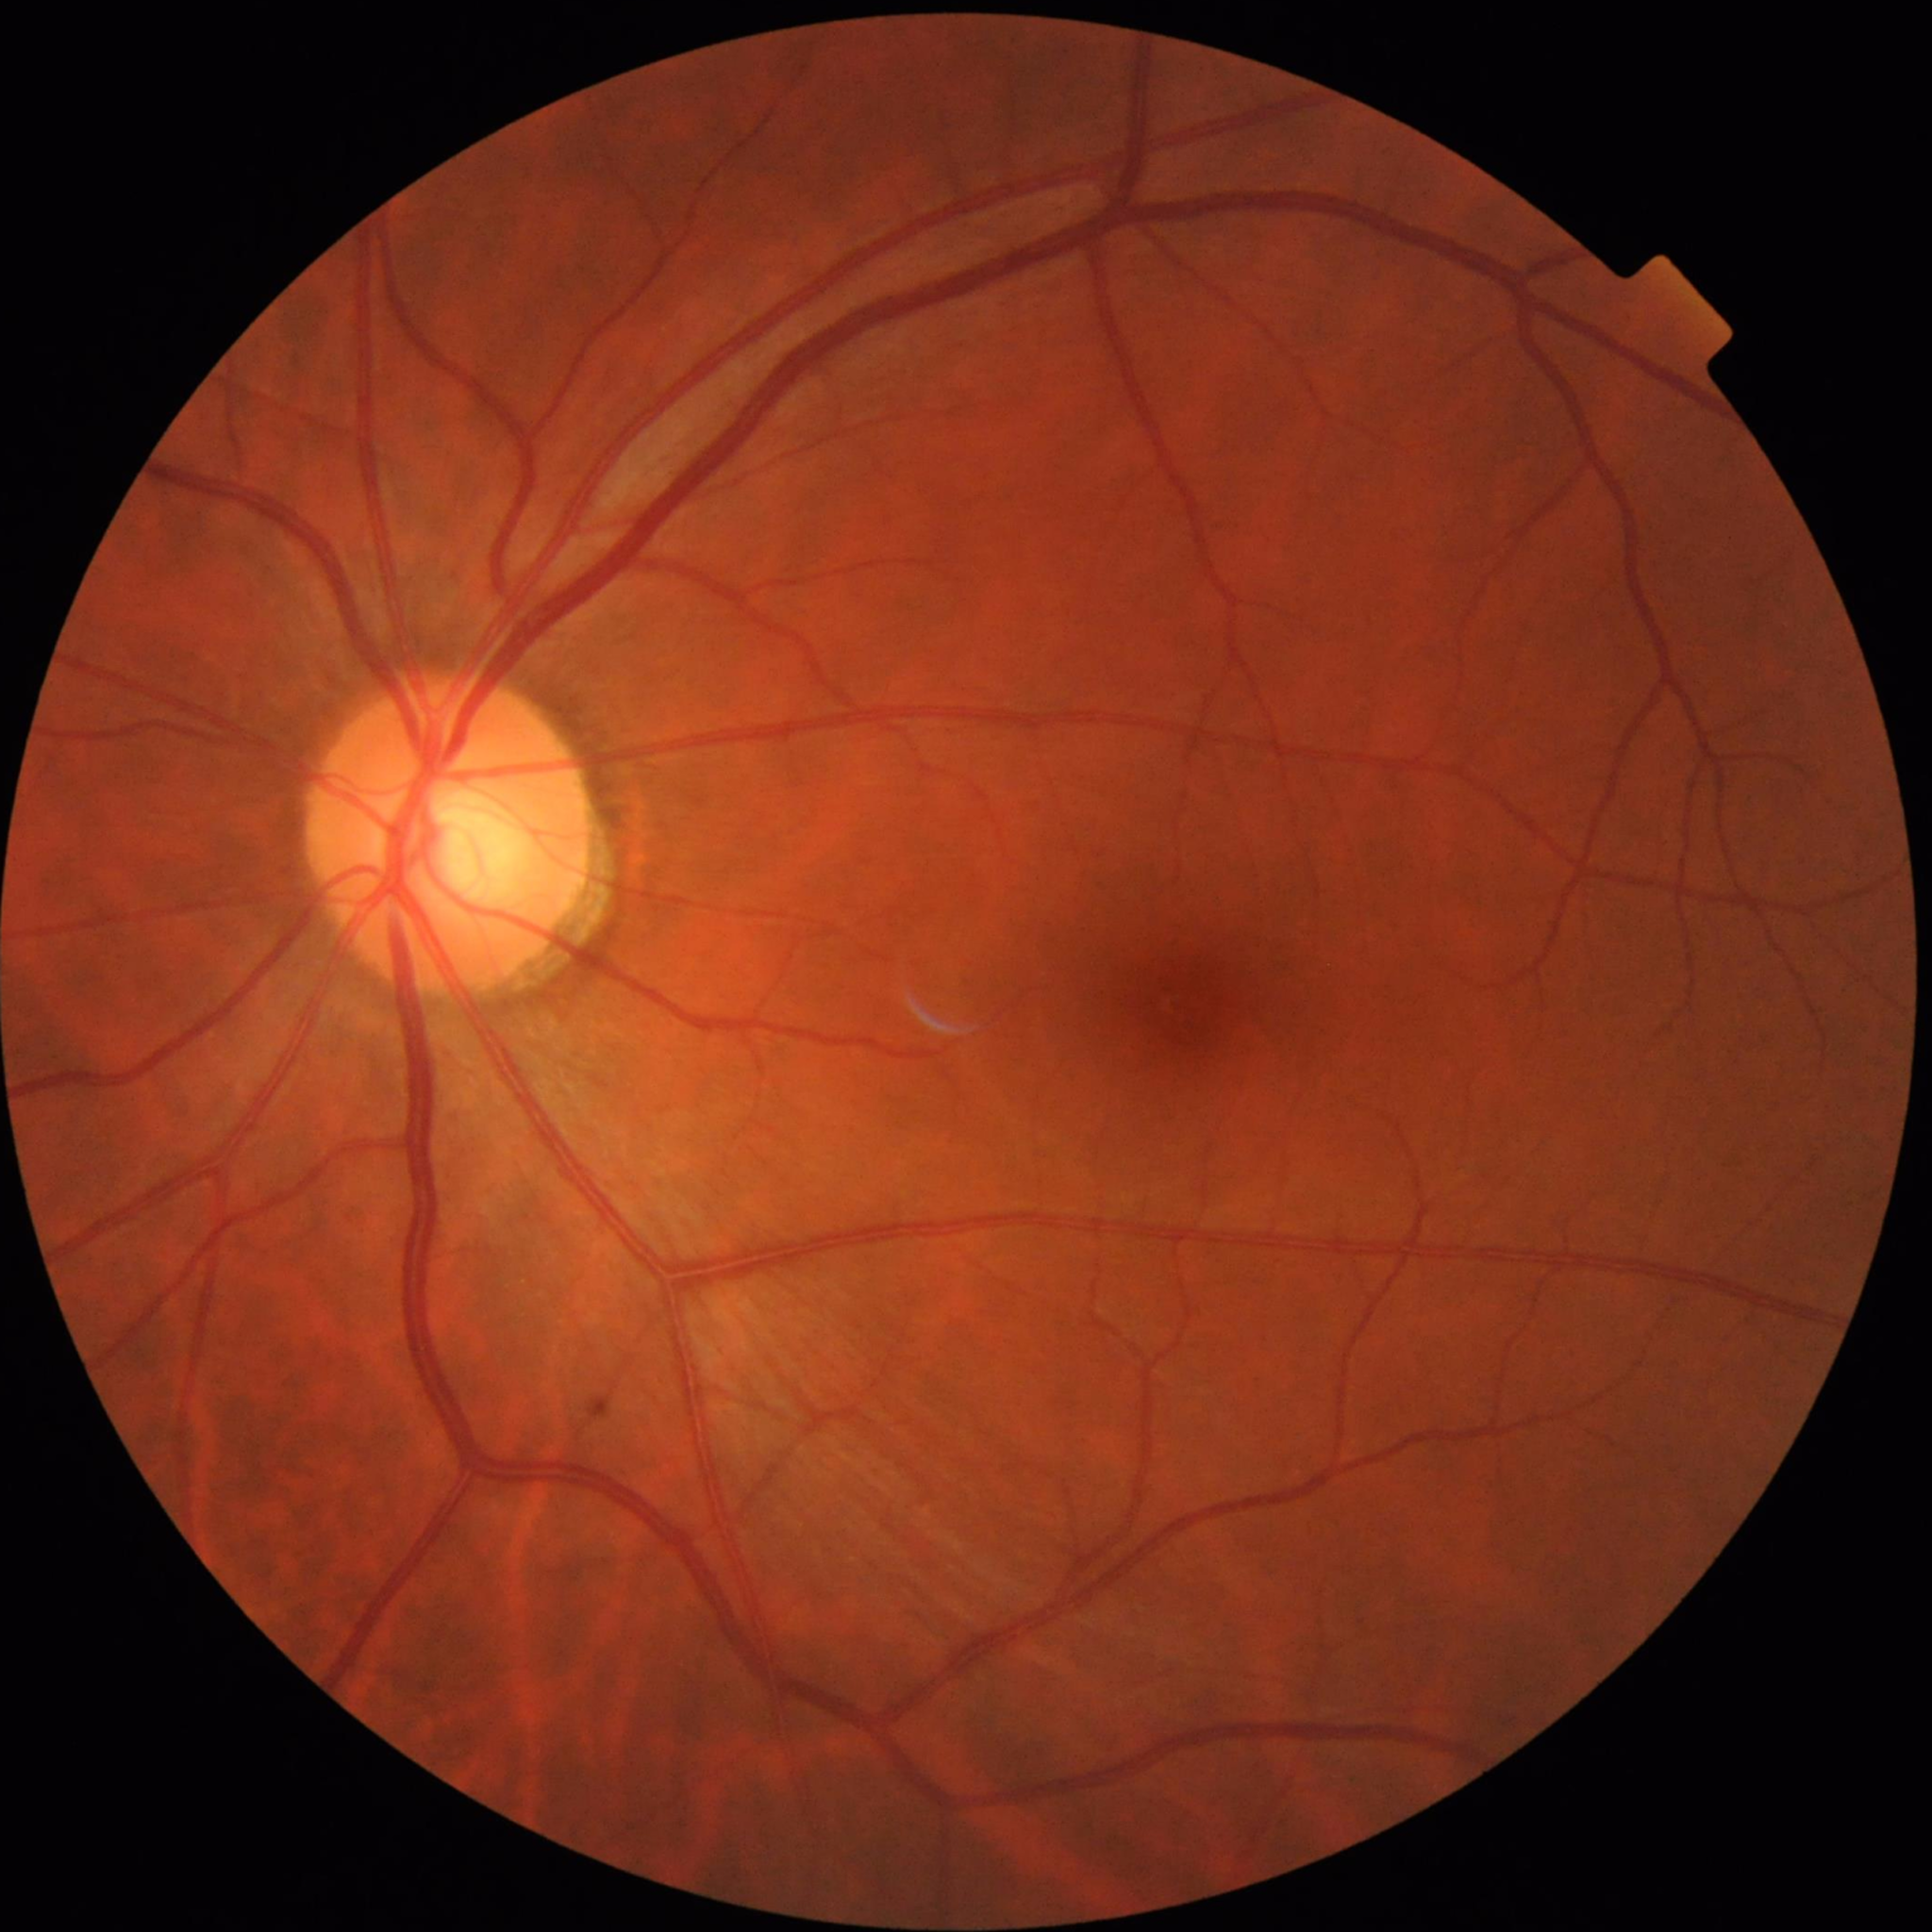

From a control without AMD, diabetic retinopathy, or glaucoma.